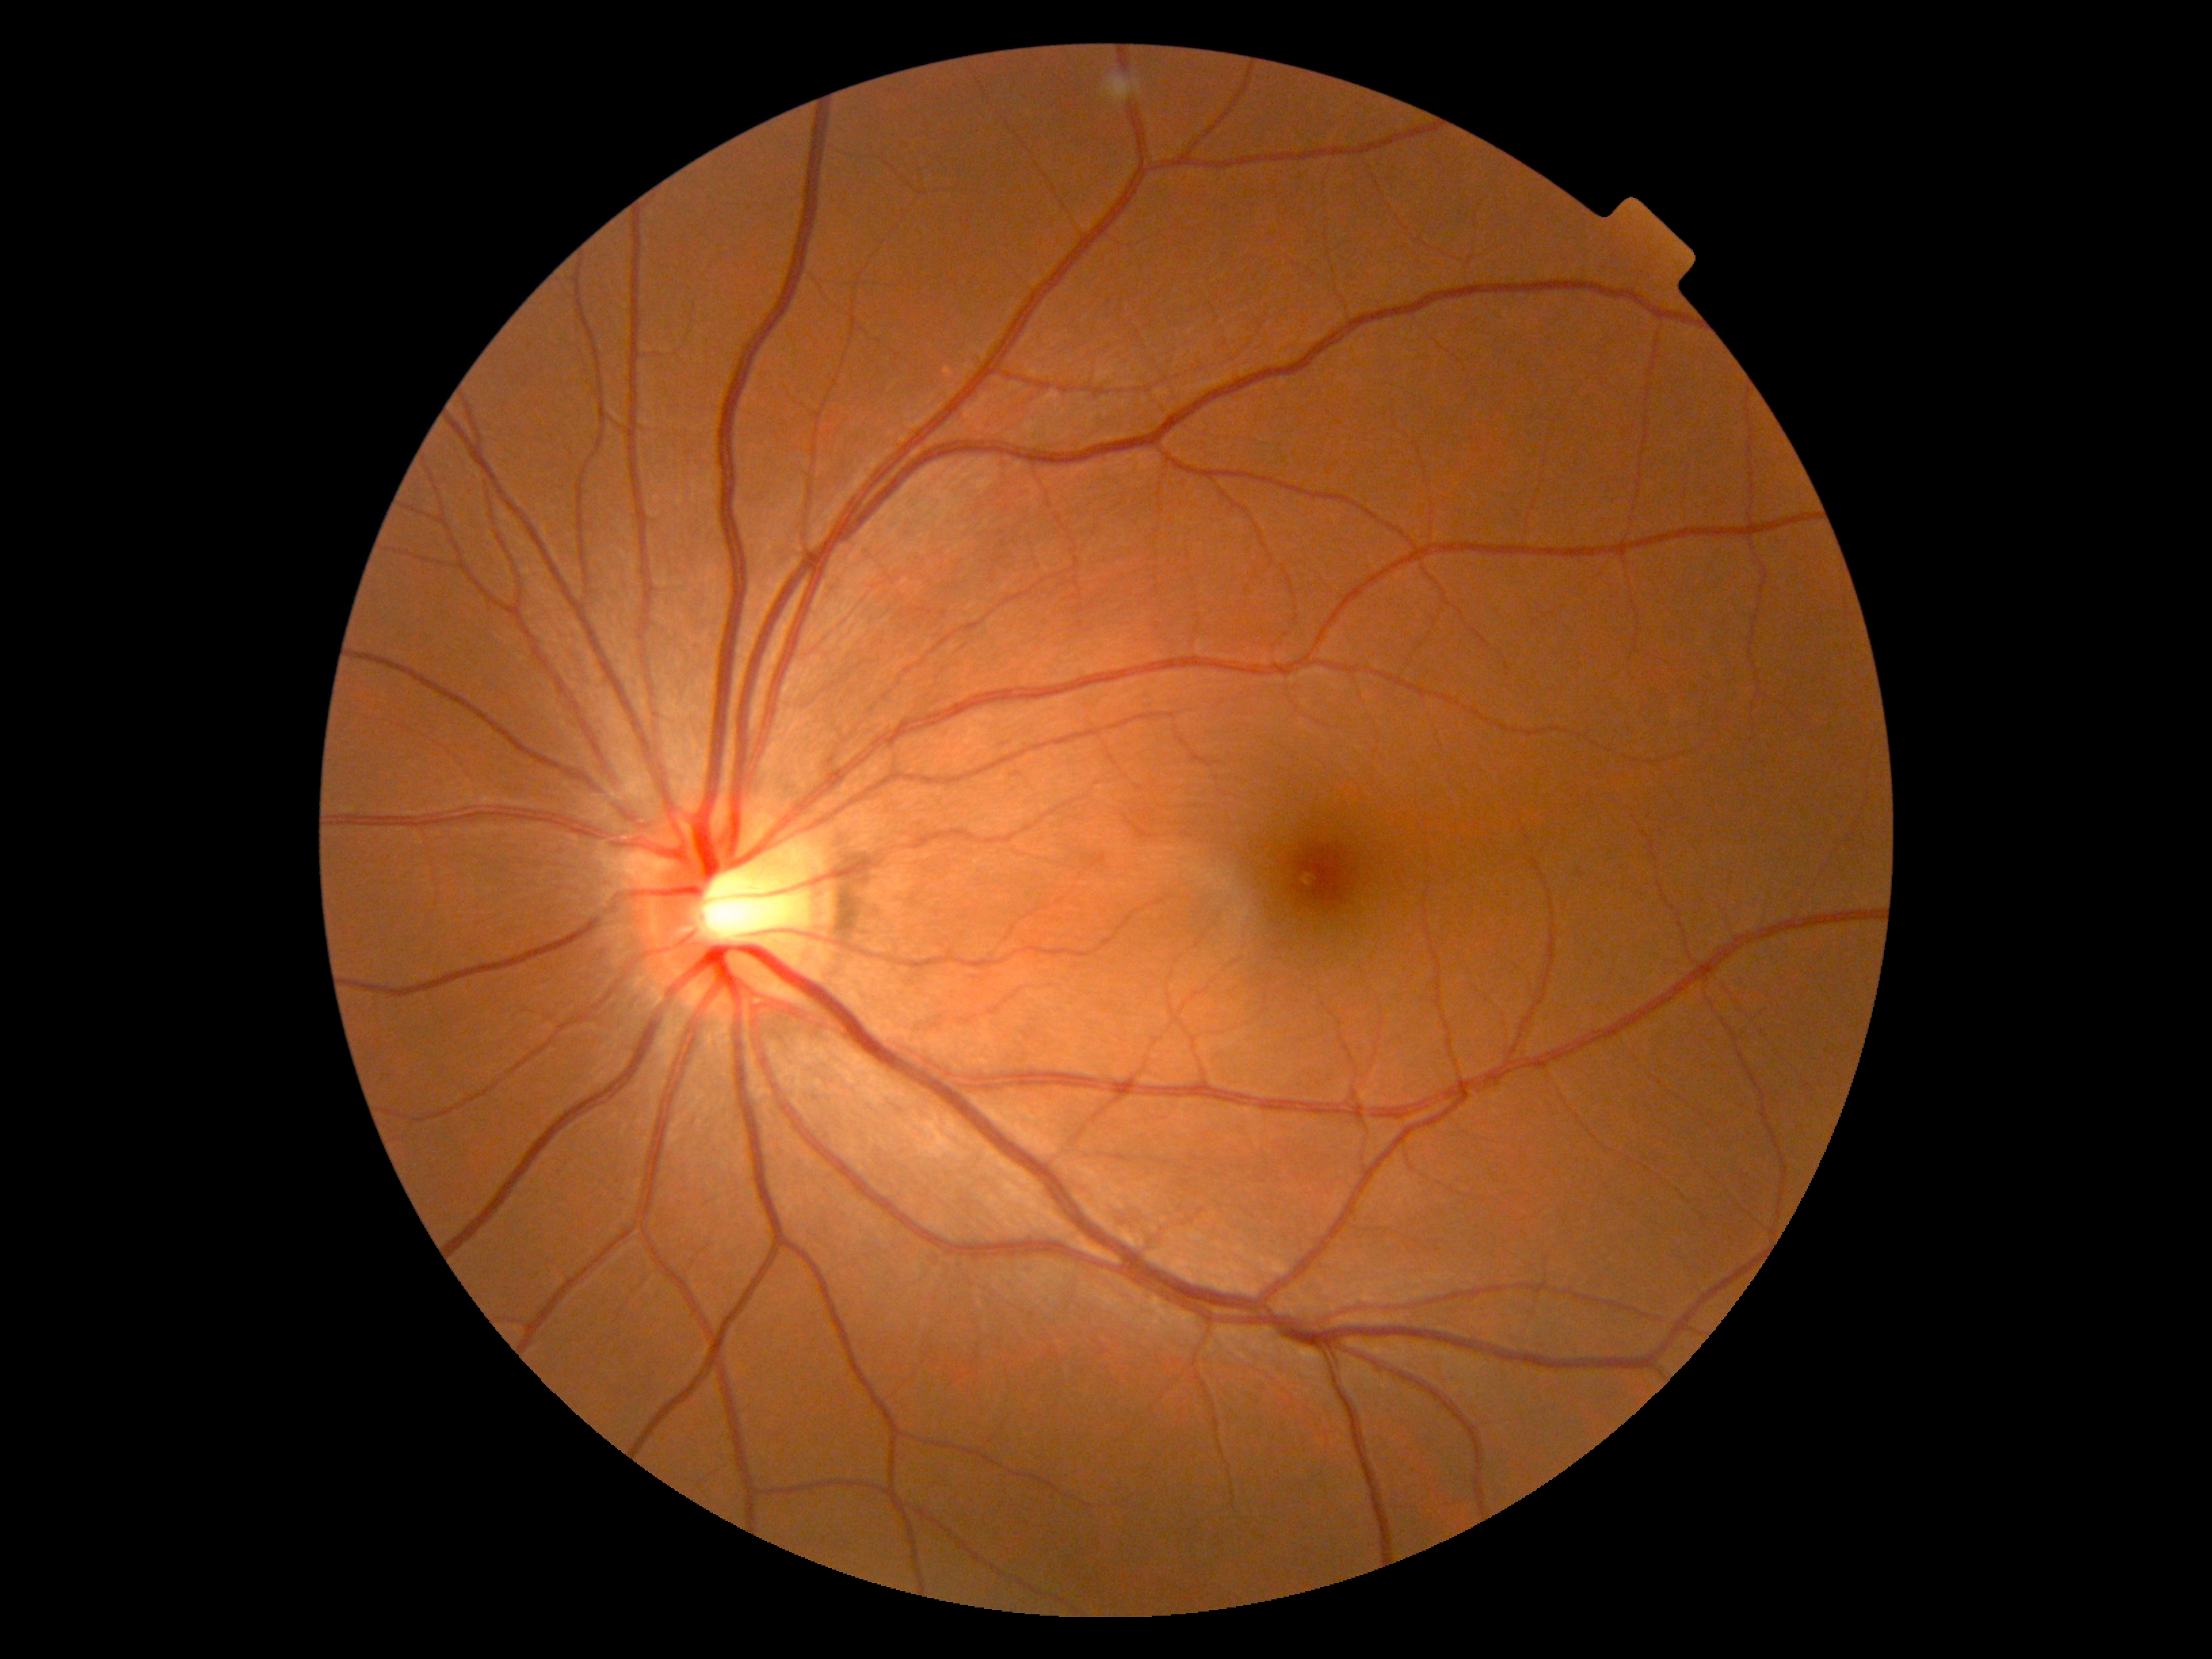
Diabetic retinopathy (DR): grade 0 (no apparent retinopathy).
No diabetic retinal disease findings.